Fundus photo; 2102x1736:
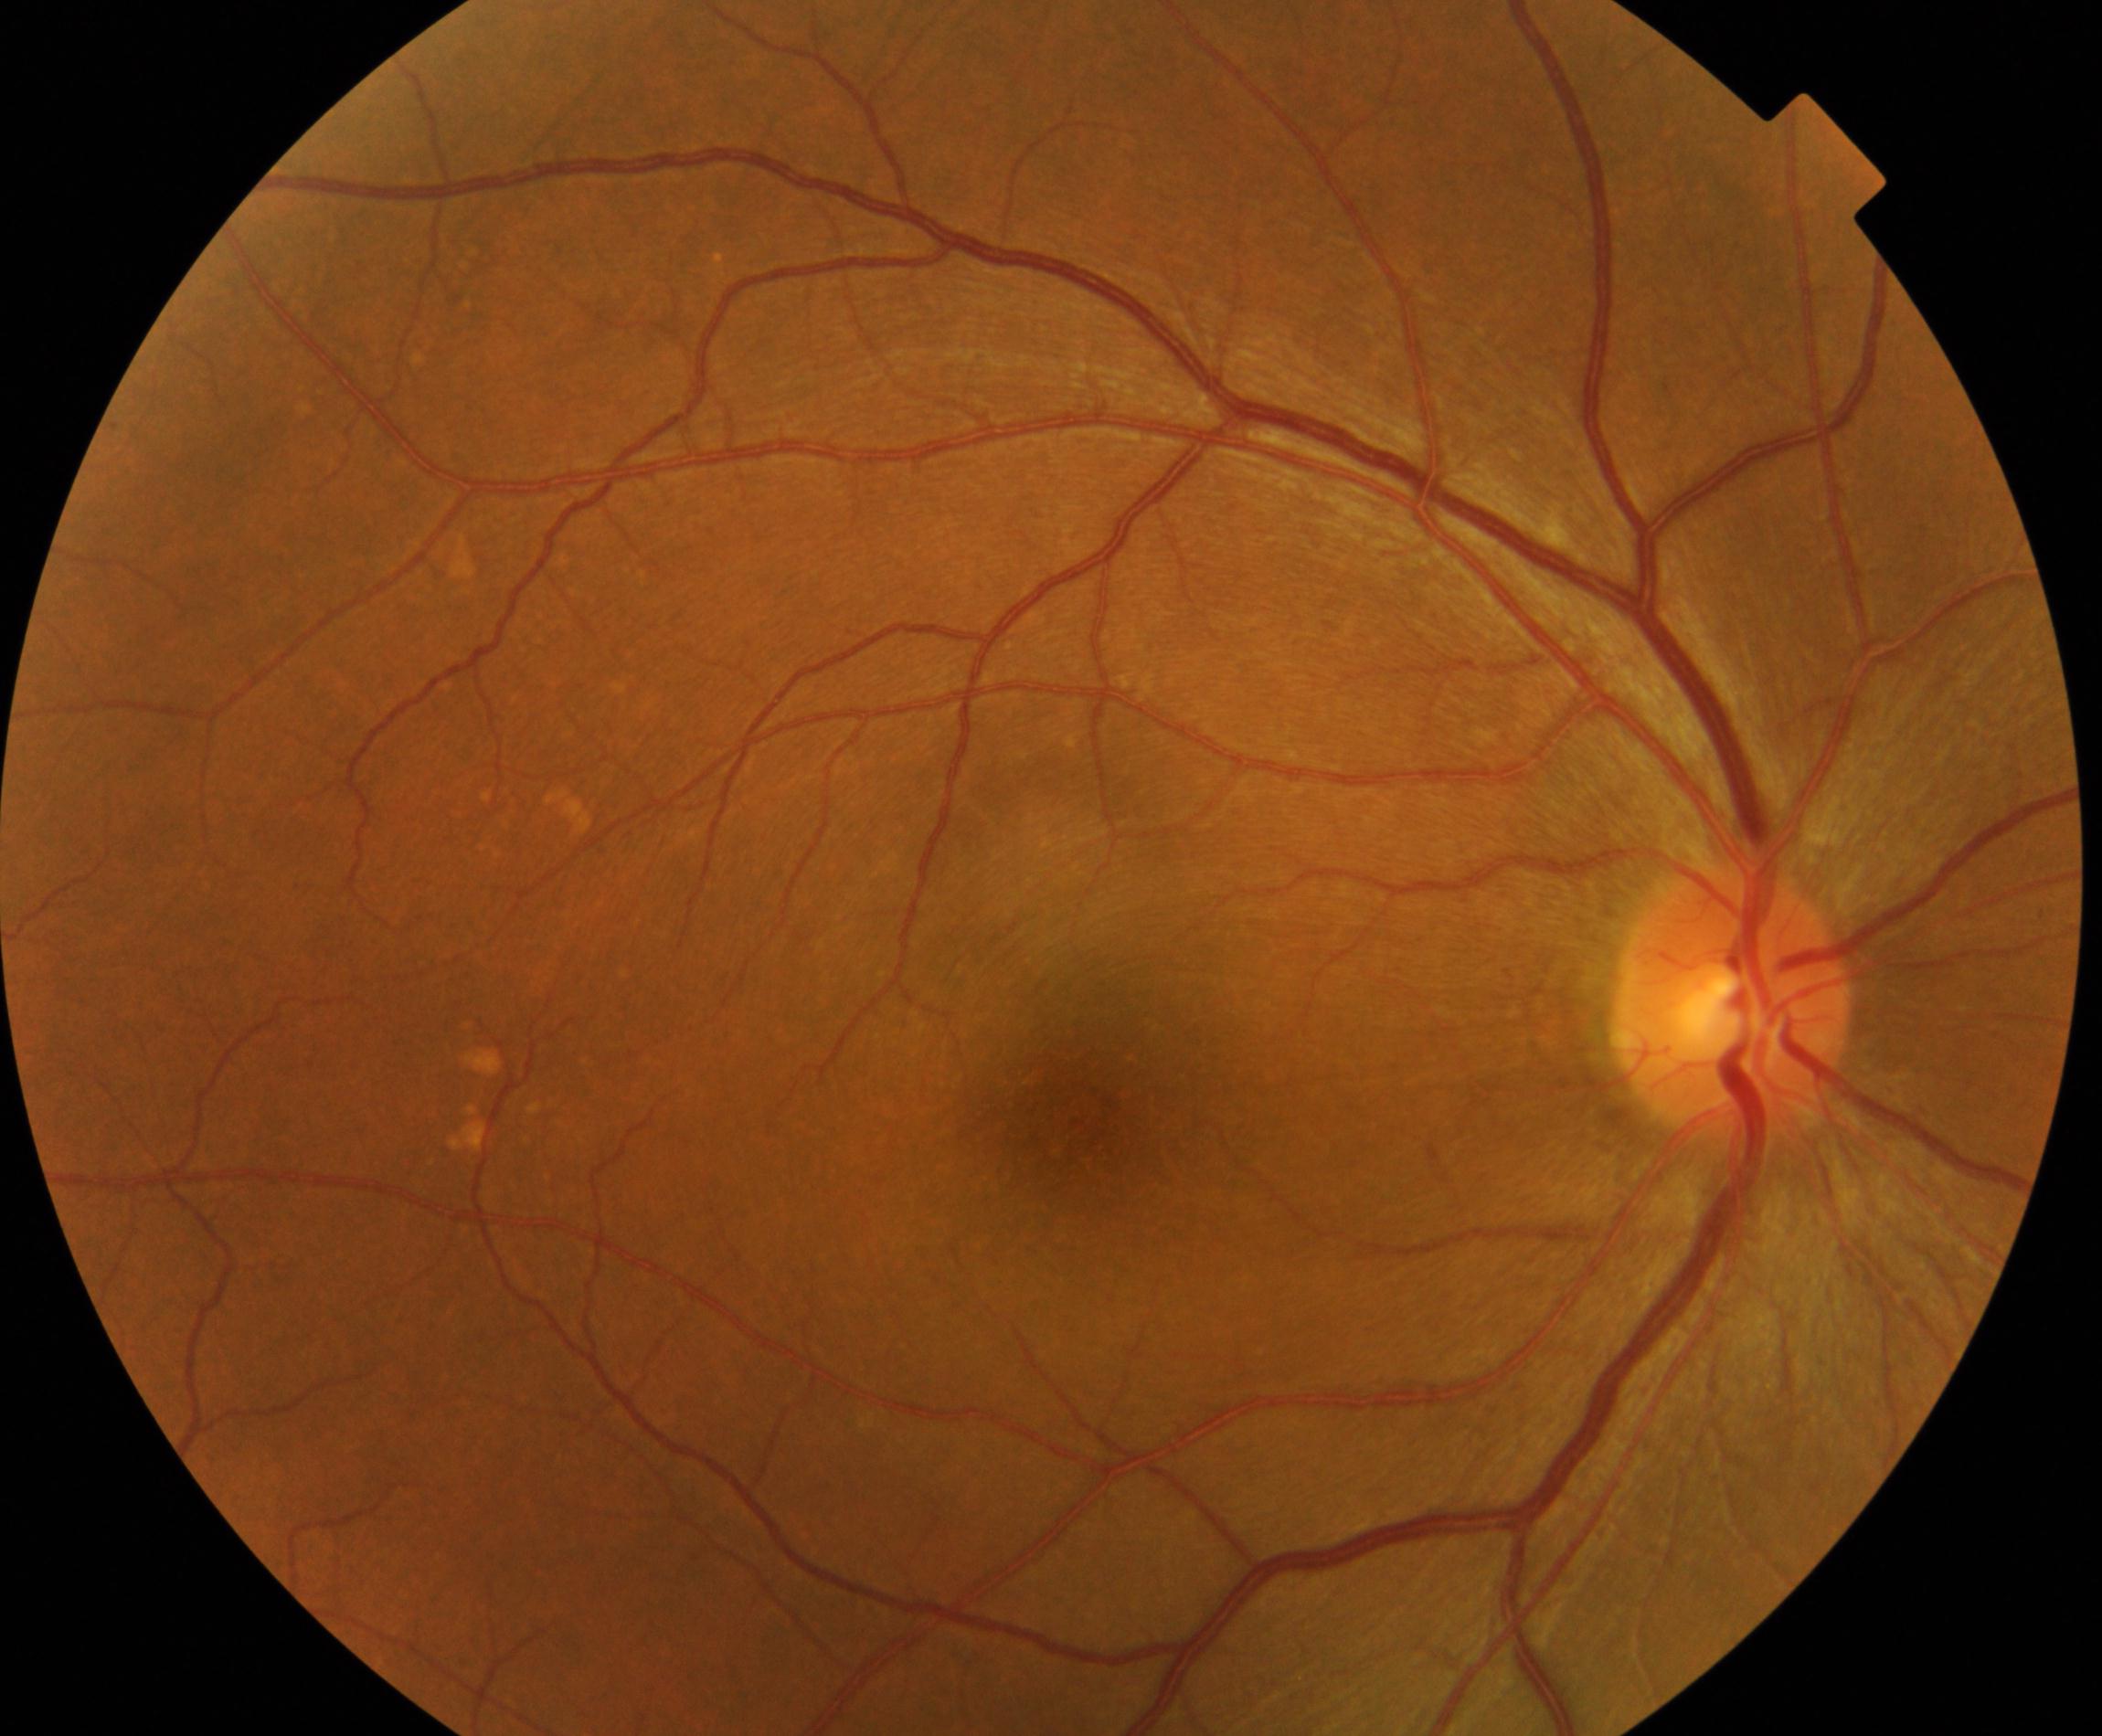
Primary finding: yellow-white spots or flecks.